45-degree field of view. 2352x1568px
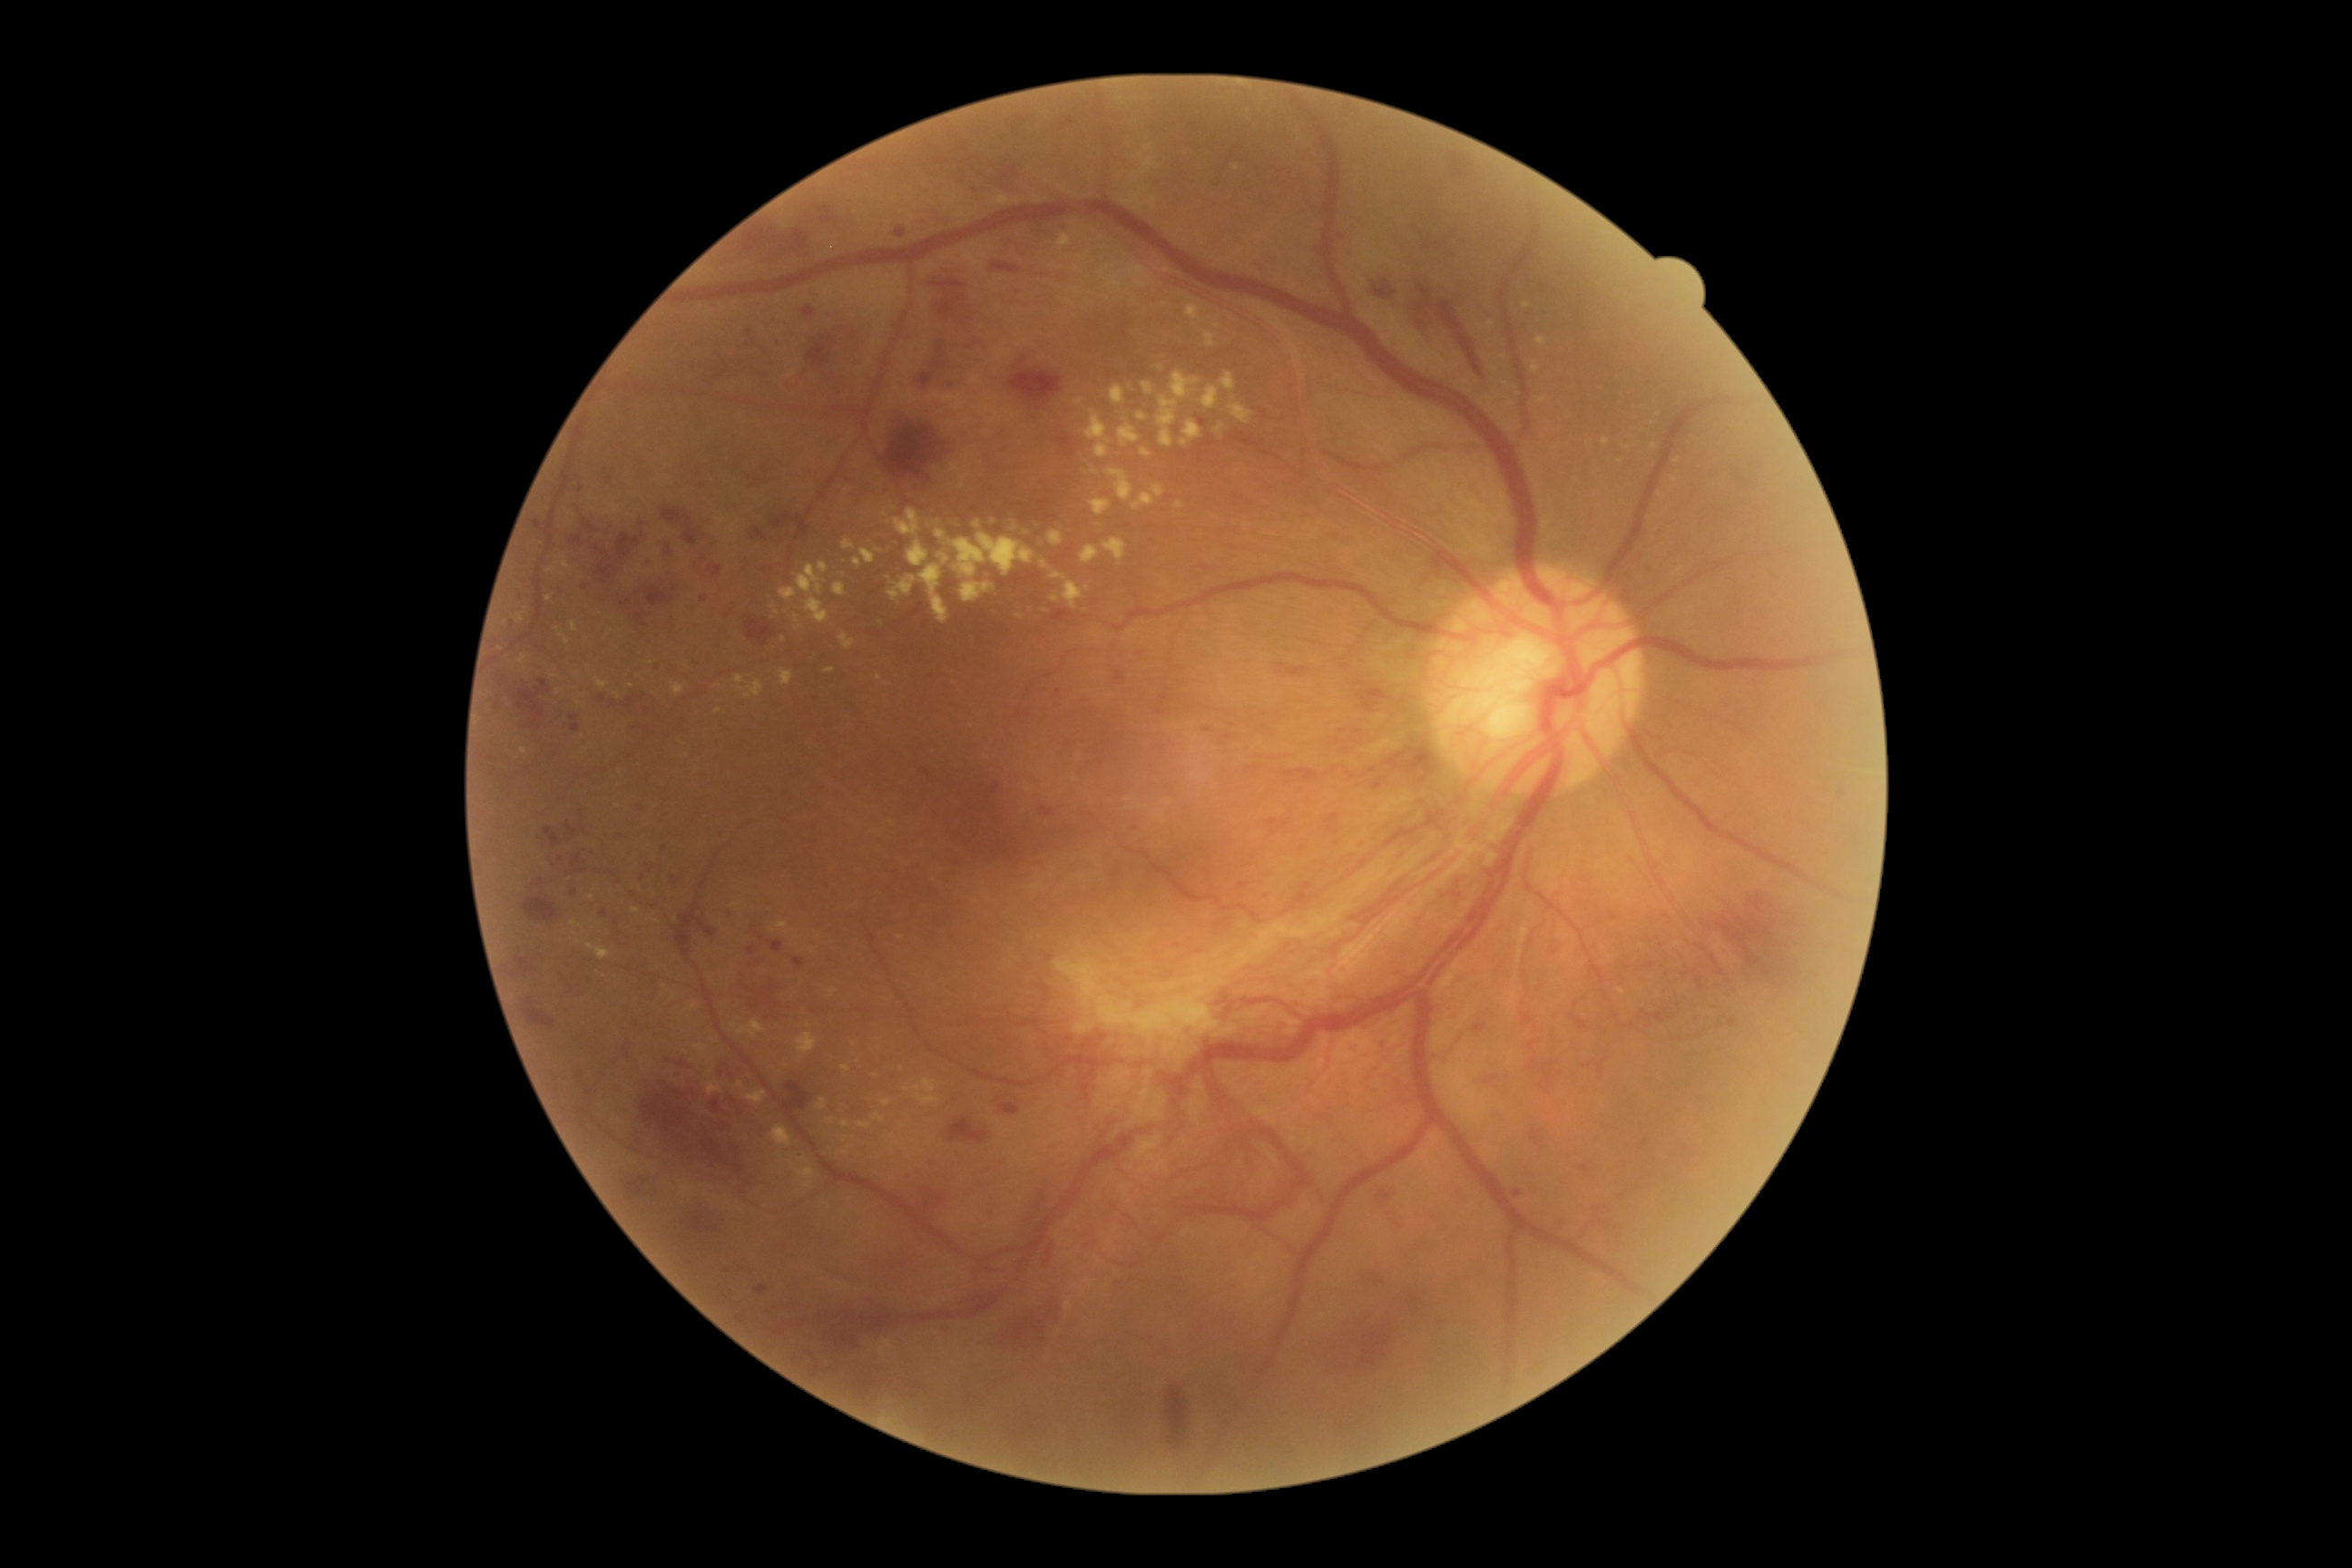

Diabetic retinopathy (DR): grade 4 (PDR)
Selected lesions:
hard exudates (EXs) (continued): bbox=(917, 1093, 939, 1106) | bbox=(841, 1148, 850, 1155) | bbox=(937, 554, 950, 565) | bbox=(1104, 538, 1128, 562) | bbox=(1215, 426, 1224, 435) | bbox=(936, 531, 946, 540) | bbox=(1482, 322, 1494, 331) | bbox=(734, 674, 765, 700) | bbox=(707, 1083, 721, 1095) | bbox=(587, 945, 611, 961)
Additional small EXs near [x=784, y=640] | [x=1620, y=462] | [x=618, y=695] | [x=1075, y=779] | [x=1661, y=495] | [x=505, y=623] | [x=908, y=1157] | [x=717, y=711]